Without pupil dilation · 45-degree field of view · modified Davis grading · NIDEK AFC-230: 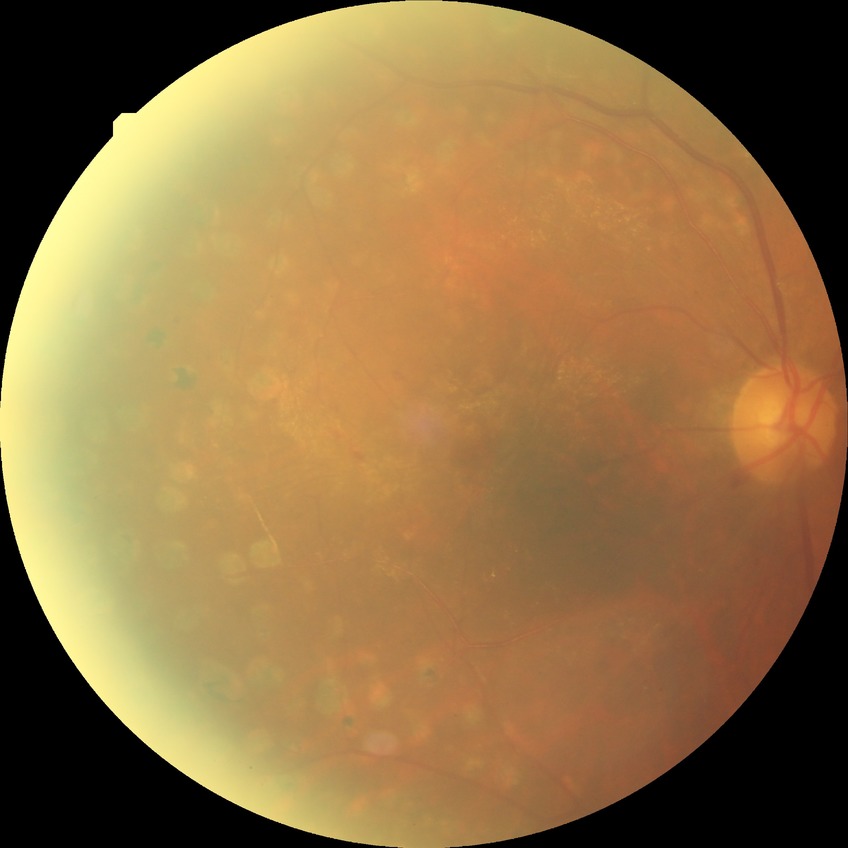

Findings:
- diabetic retinopathy (DR): proliferative diabetic retinopathy (PDR)